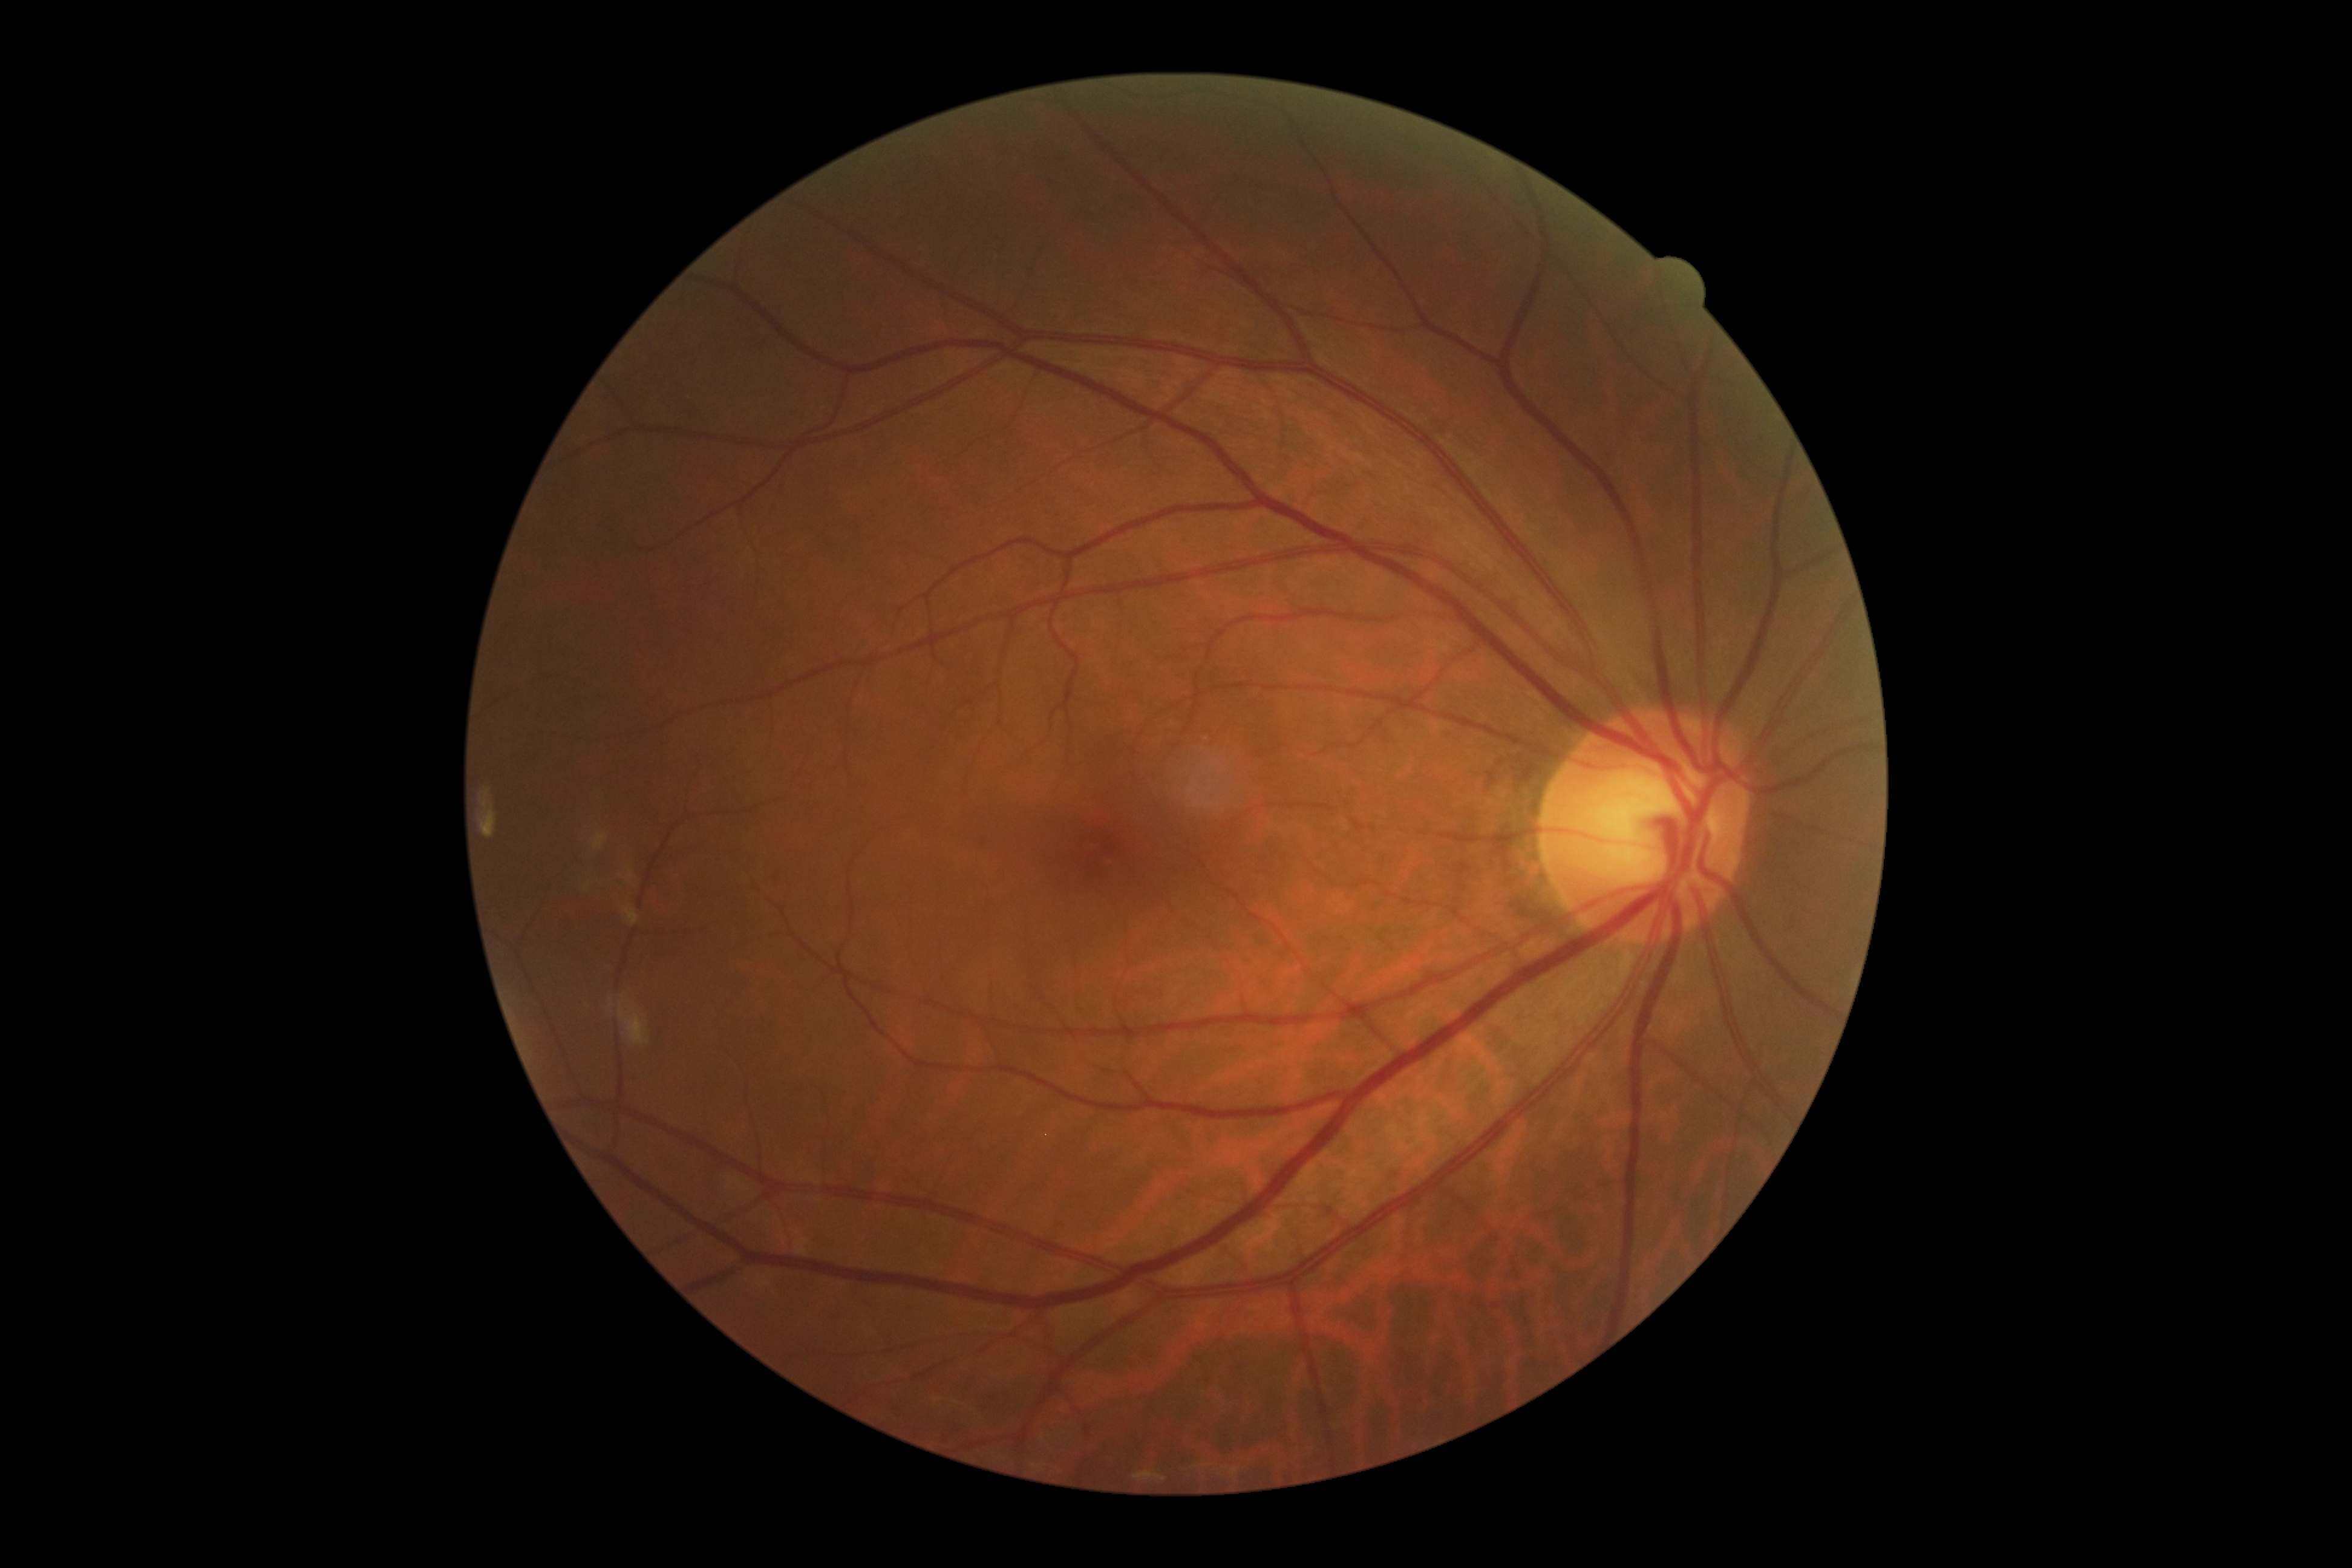 {"dr_grade": "grade 0 (no apparent retinopathy)"}